Camera: Clarity RetCam 3 (130° FOV) · wide-field fundus photograph of an infant:
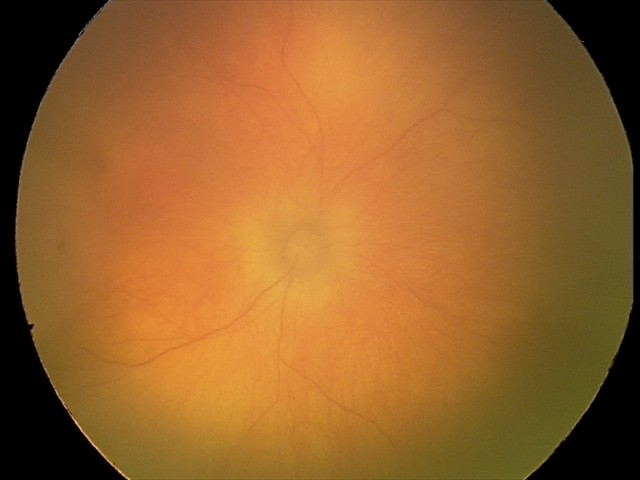
Impression: physiological appearance with no retinal pathology.